1932 by 1916 pixels
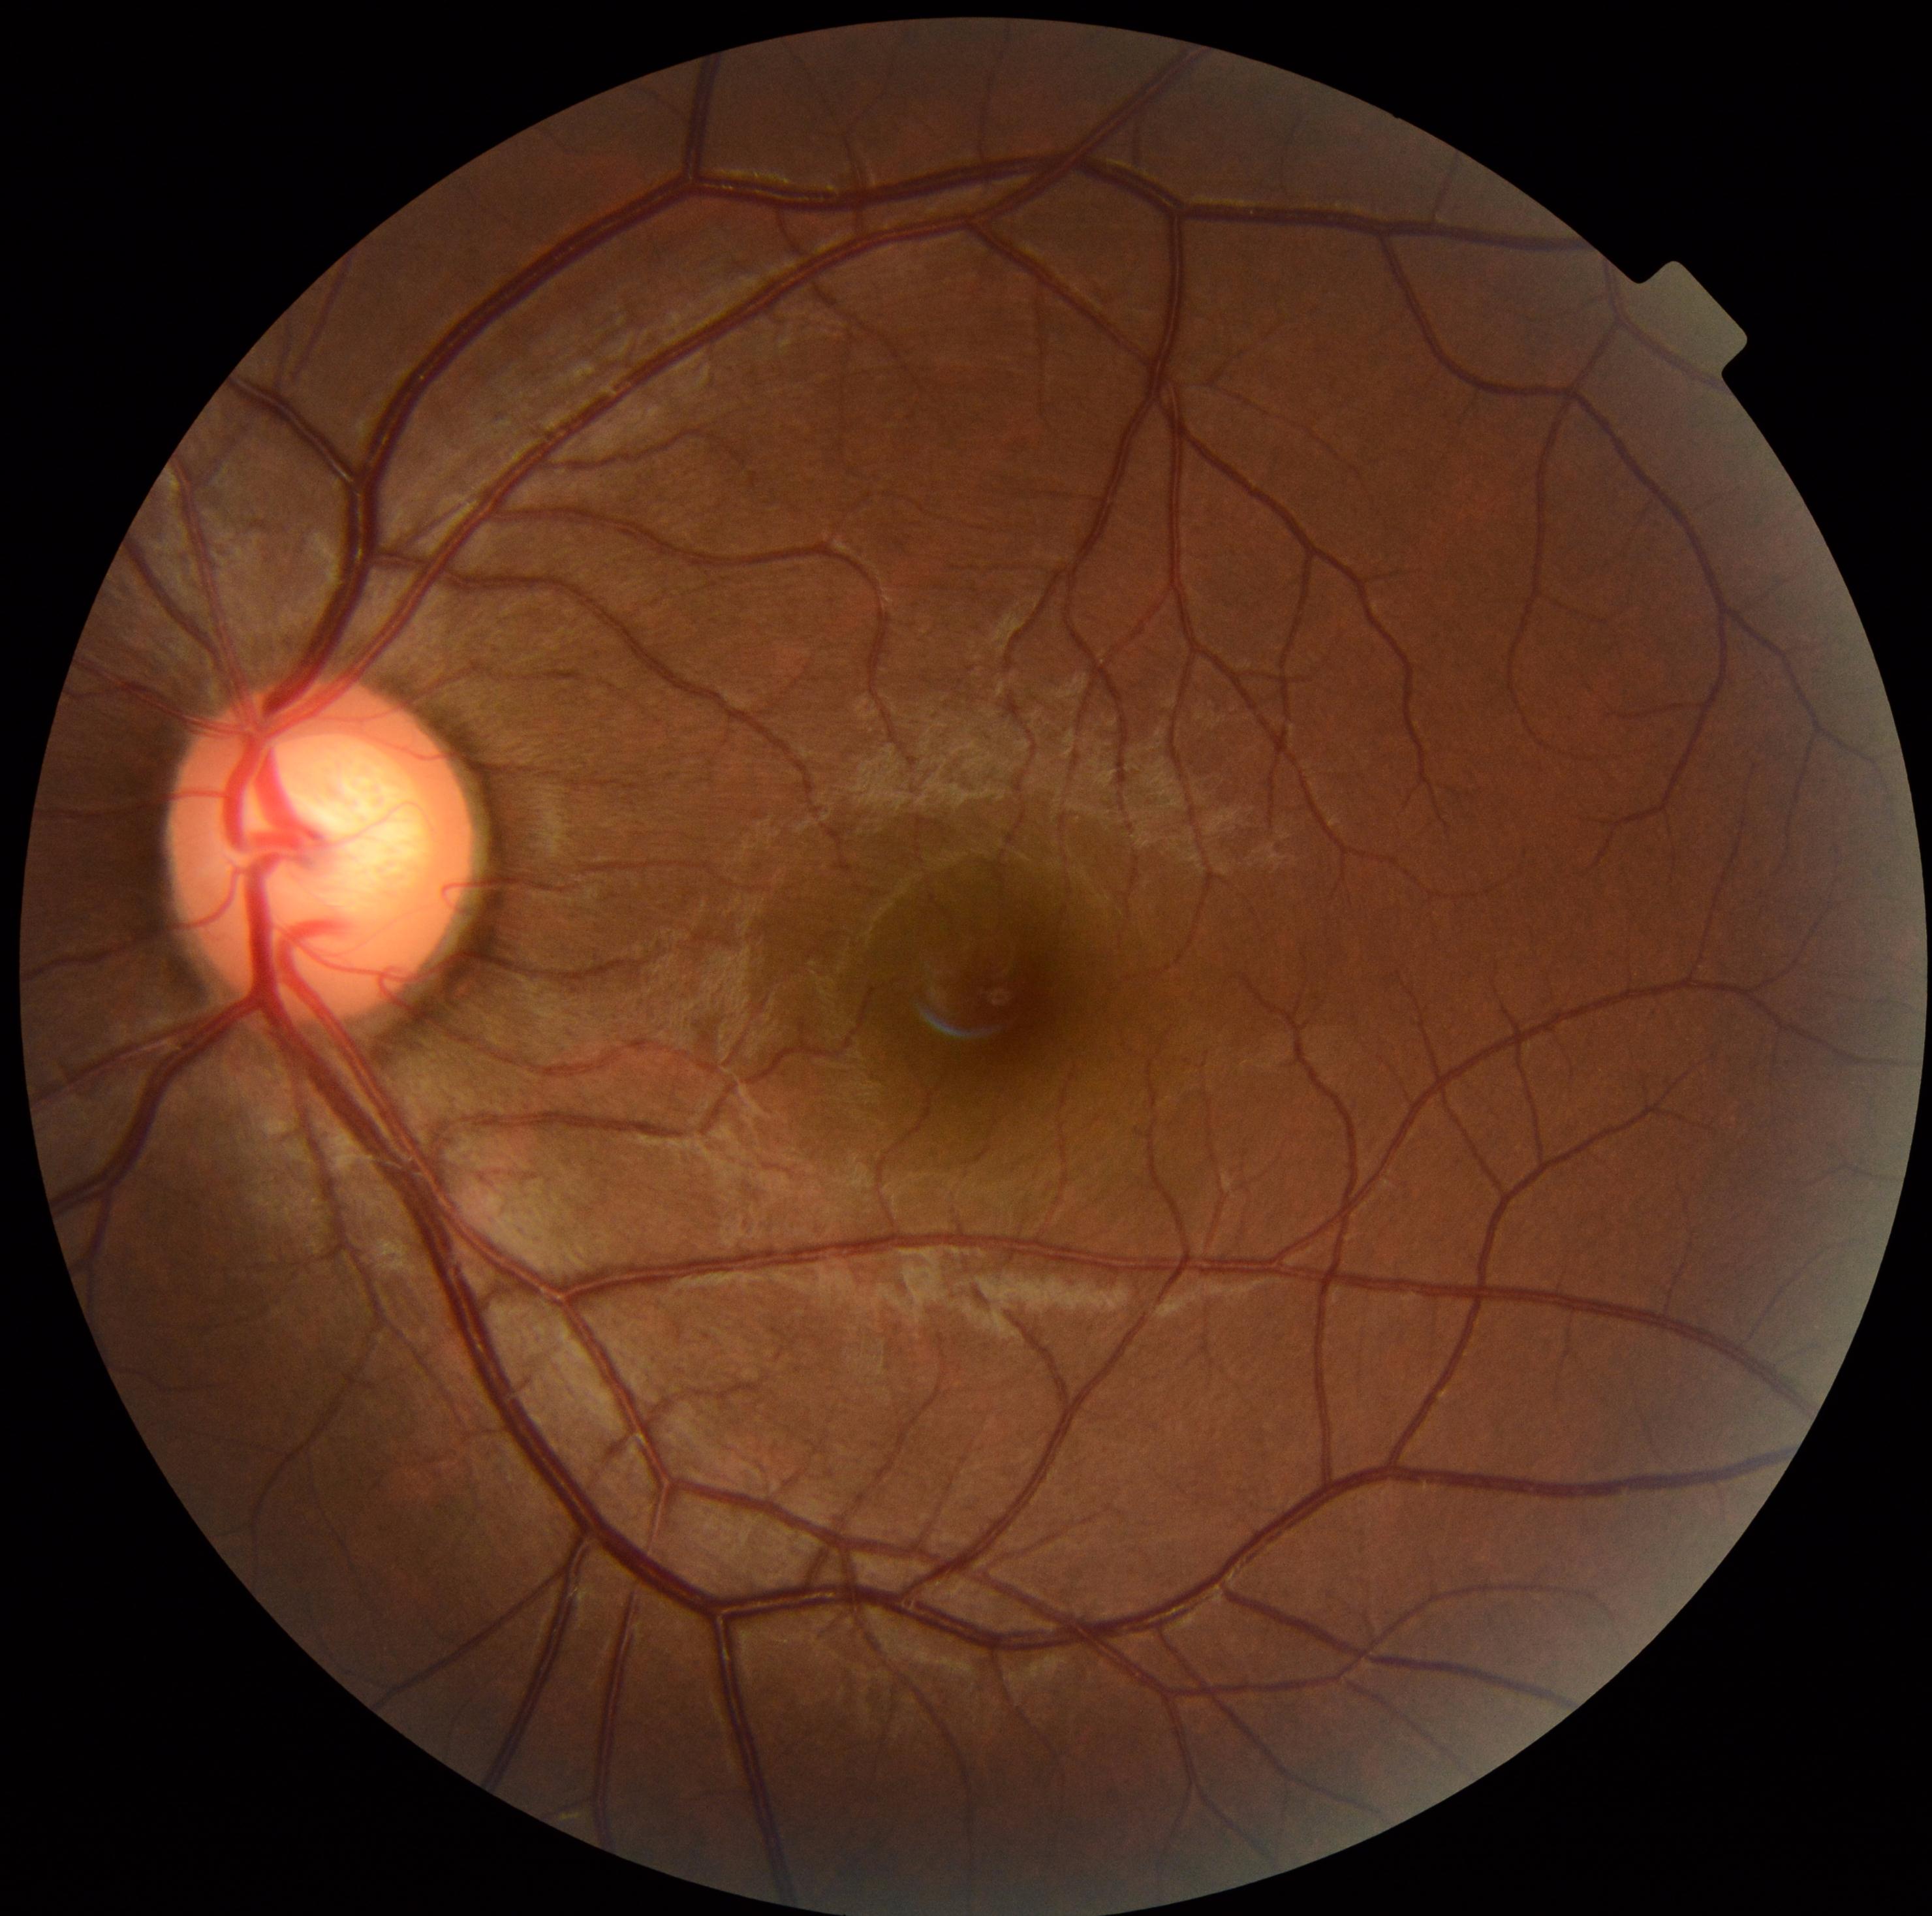

DR grade@0.